Macula-centered, 1932 by 1932 pixels.
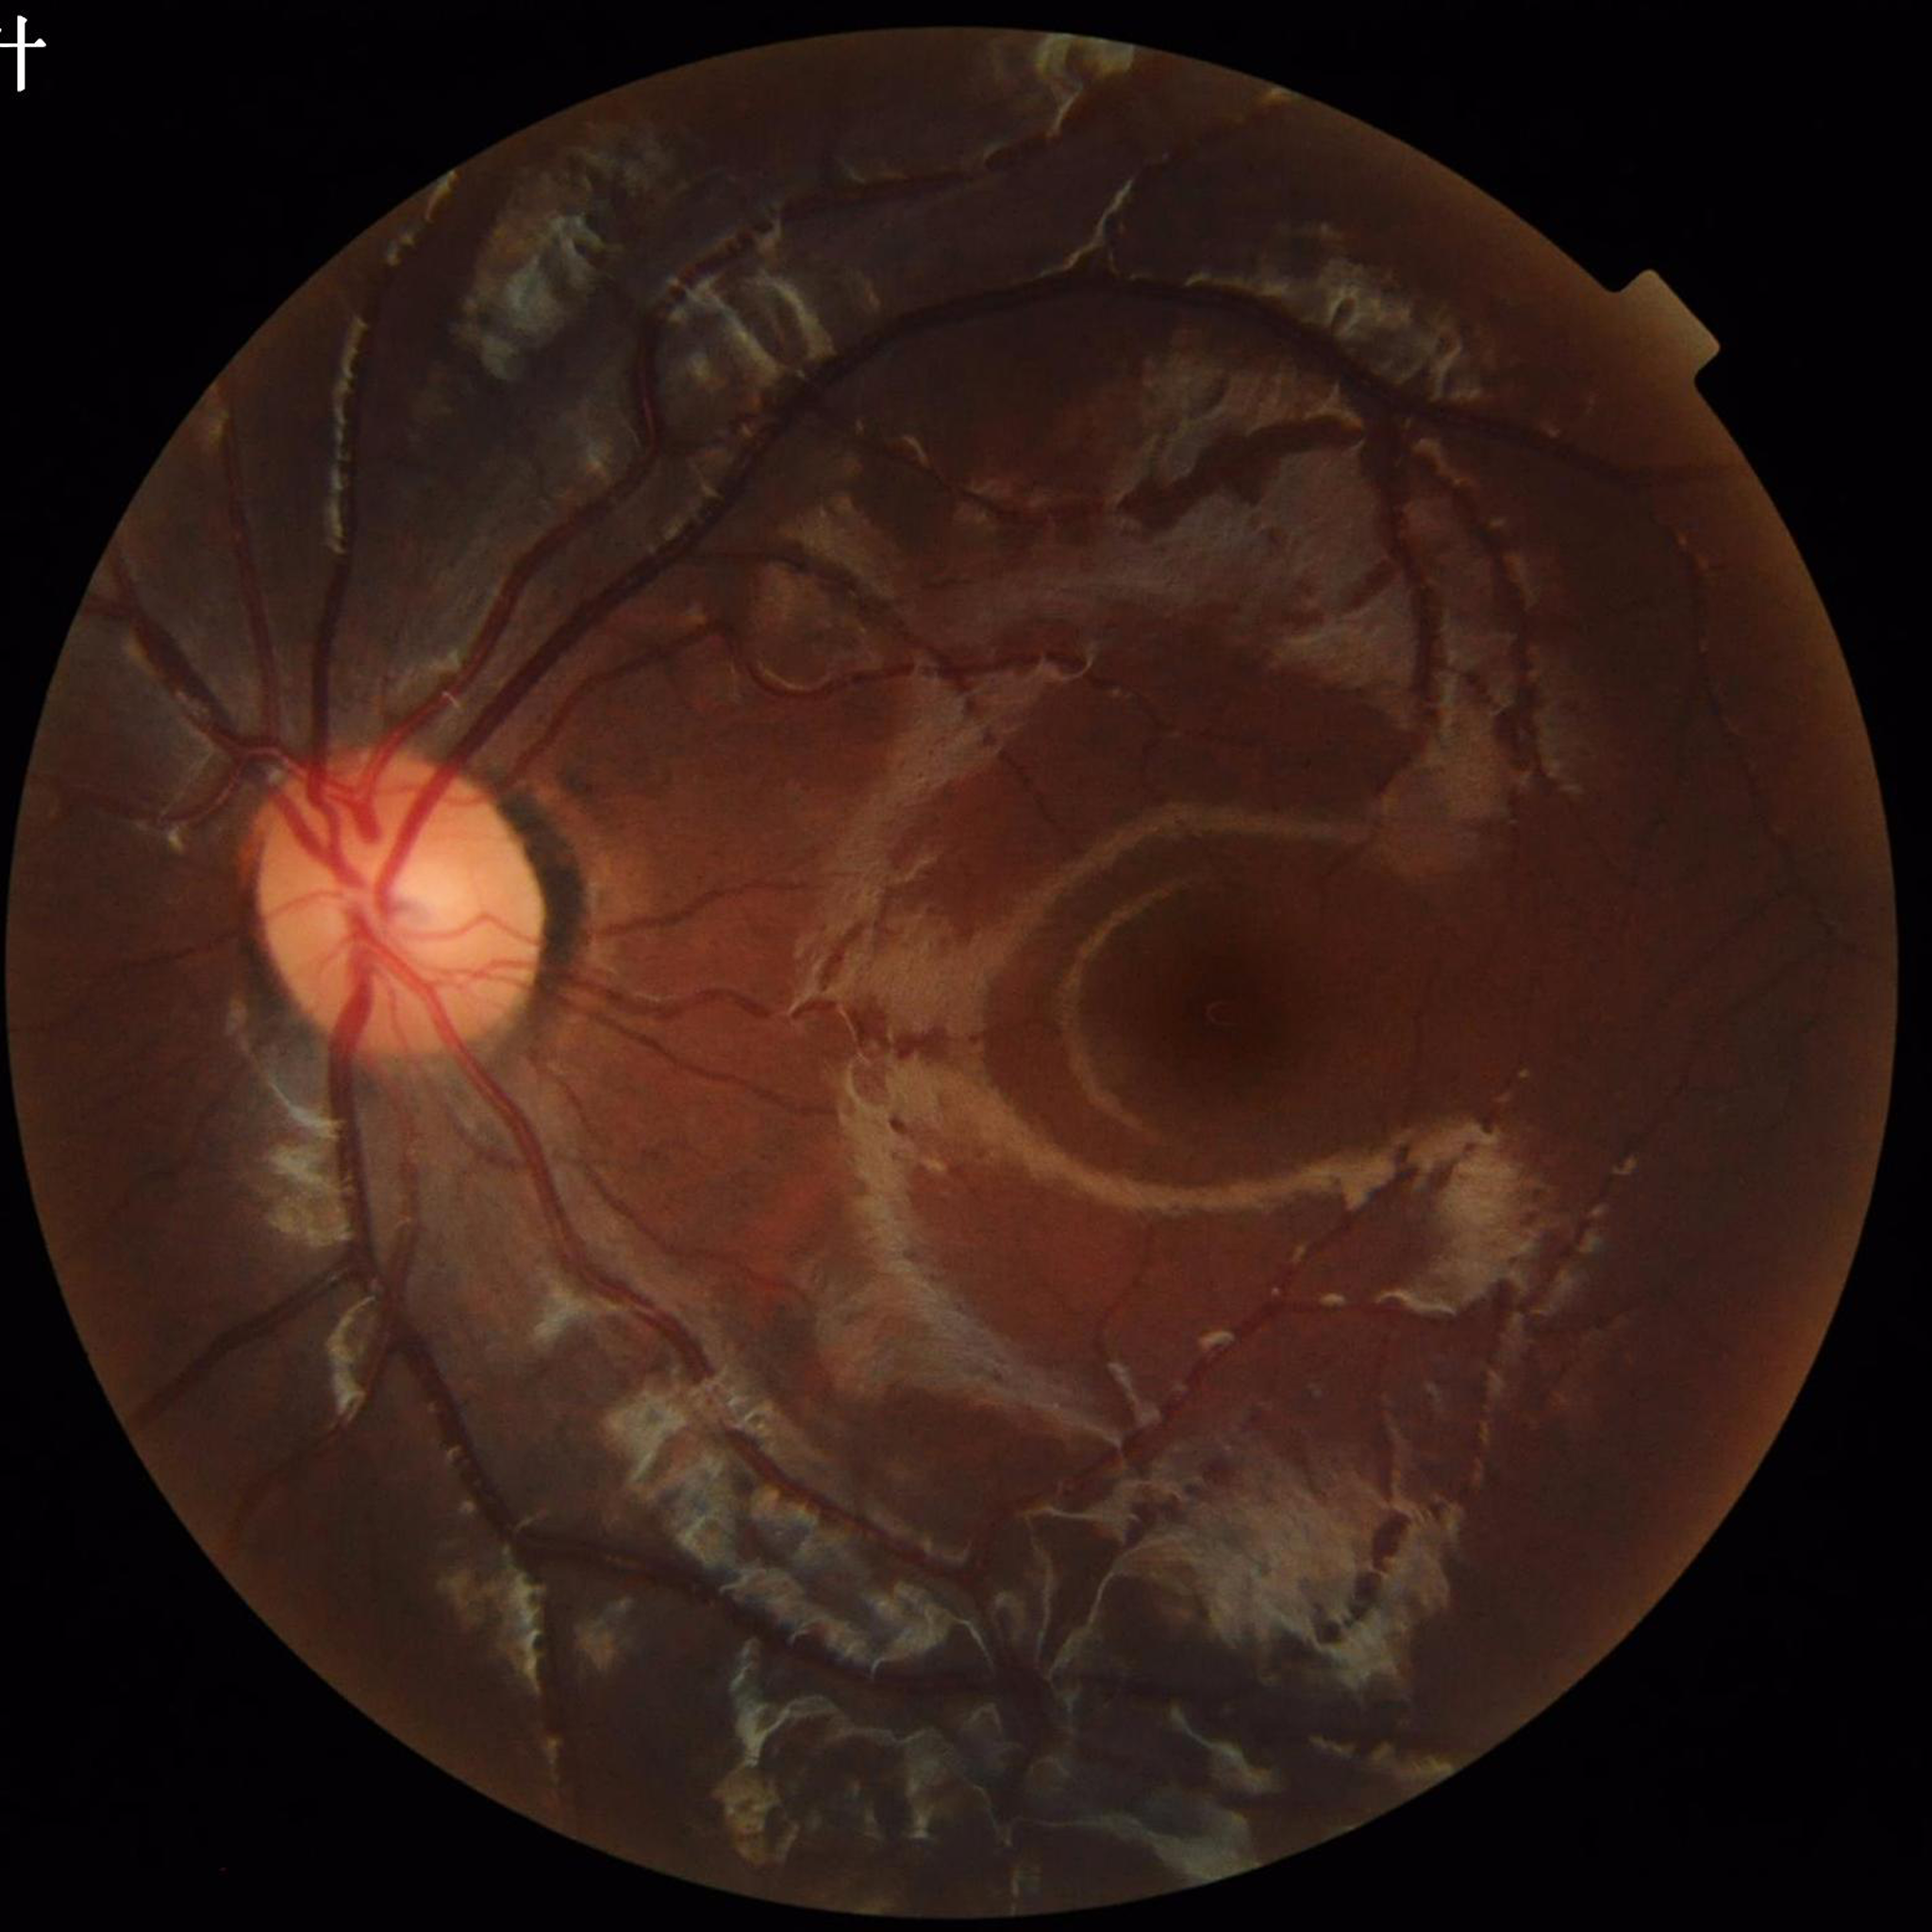

From a control without AMD, diabetic retinopathy, or glaucoma. Quality assessment: contrast adequate, illumination and color satisfactory, no blur.